Diabetic retinopathy graded by the modified Davis classification
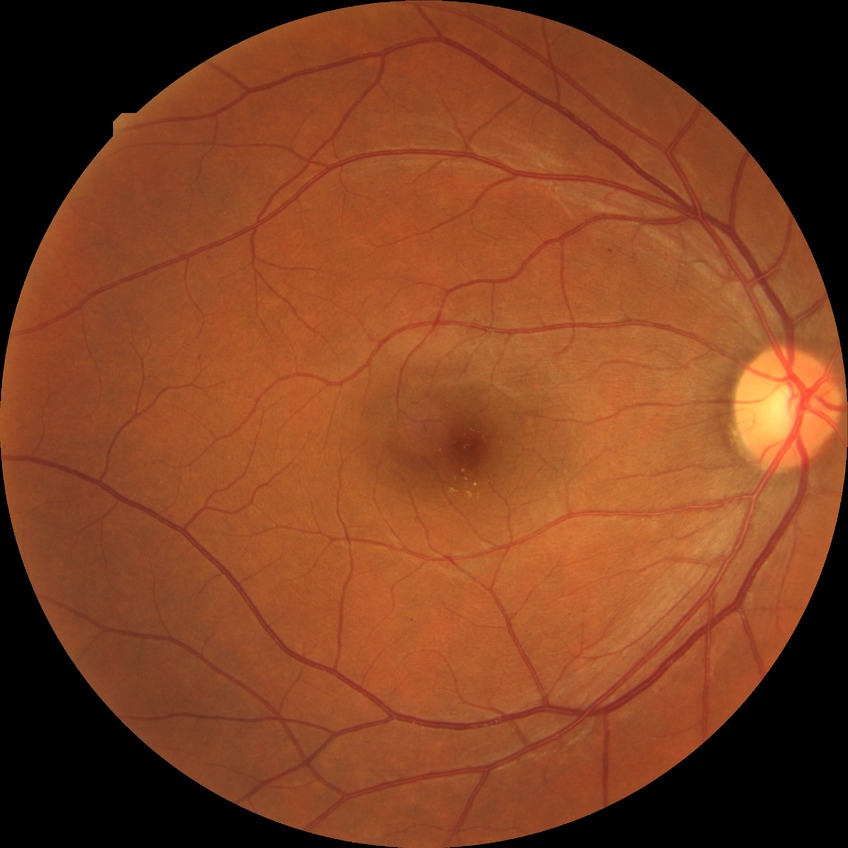
Diabetic retinopathy (DR) is SDR (simple diabetic retinopathy).